Graded on the modified Davis scale — 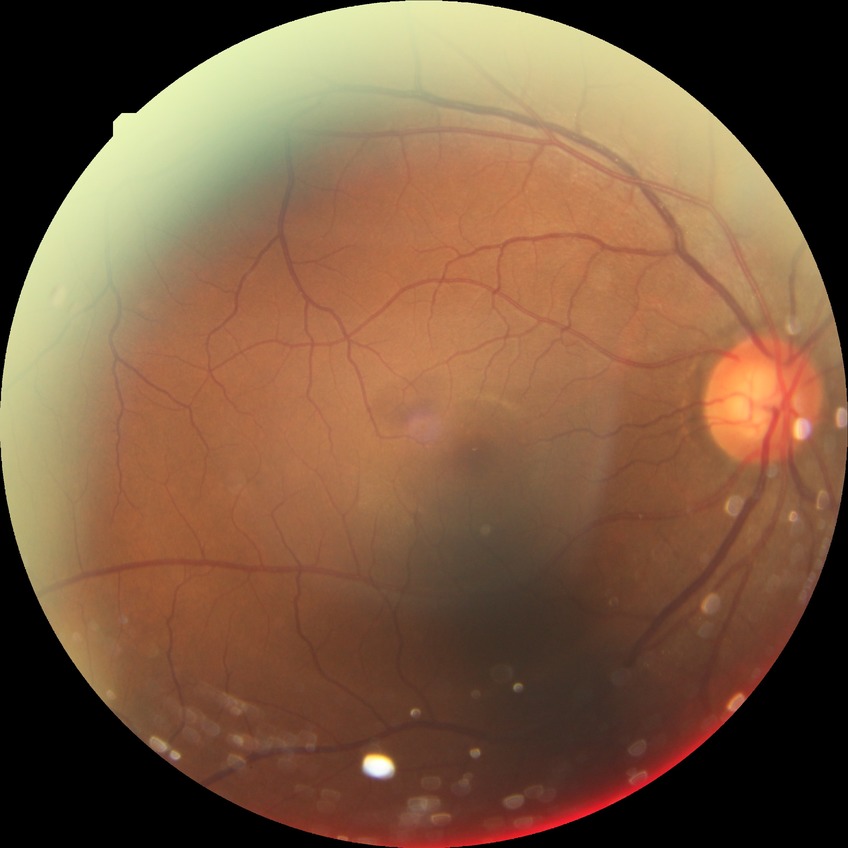

Diabetic retinopathy (DR): NDR (no diabetic retinopathy).